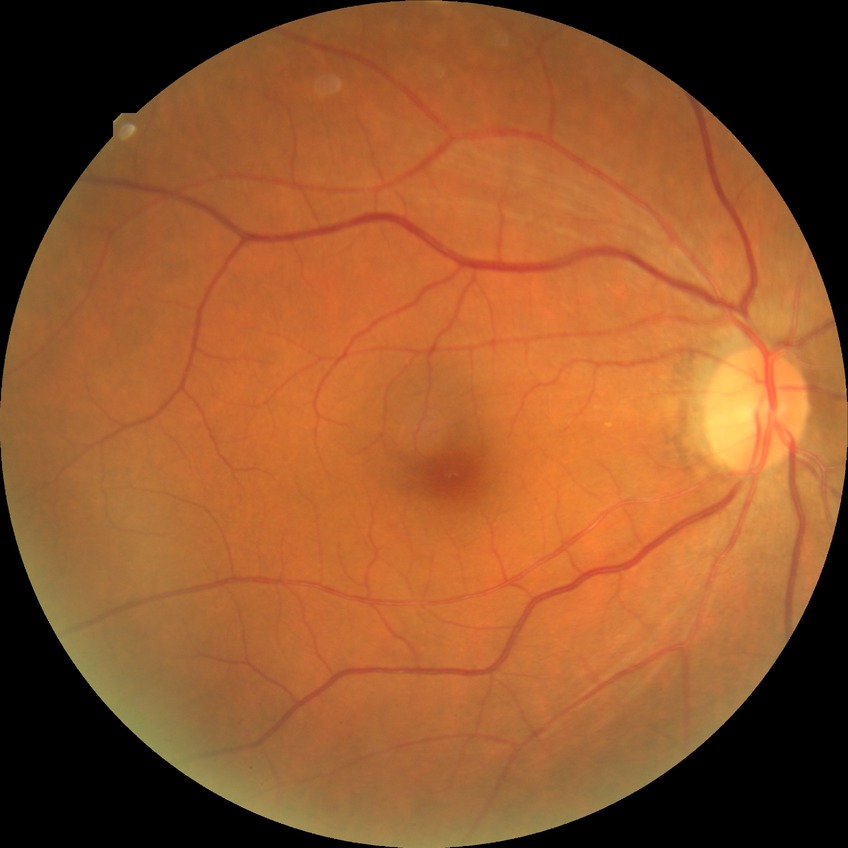 Diabetic retinopathy severity is no diabetic retinopathy.